Acquired on the Clarity RetCam 3 · 640x480 · pediatric retinal photograph (wide-field) — 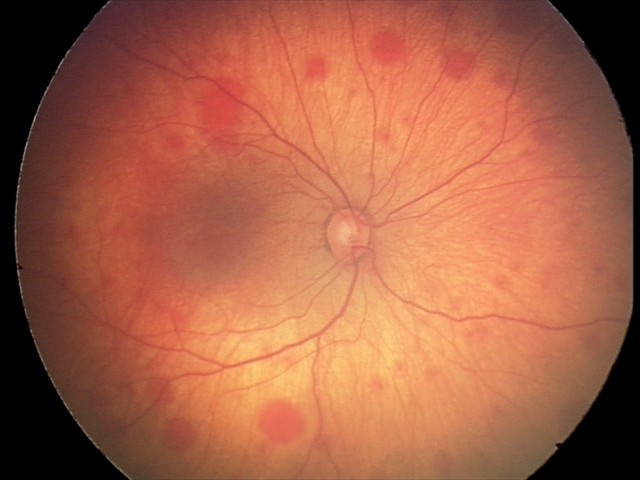
Screening: retinal hemorrhages.